848x848. Diabetic retinopathy graded by the modified Davis classification. 45-degree field of view:
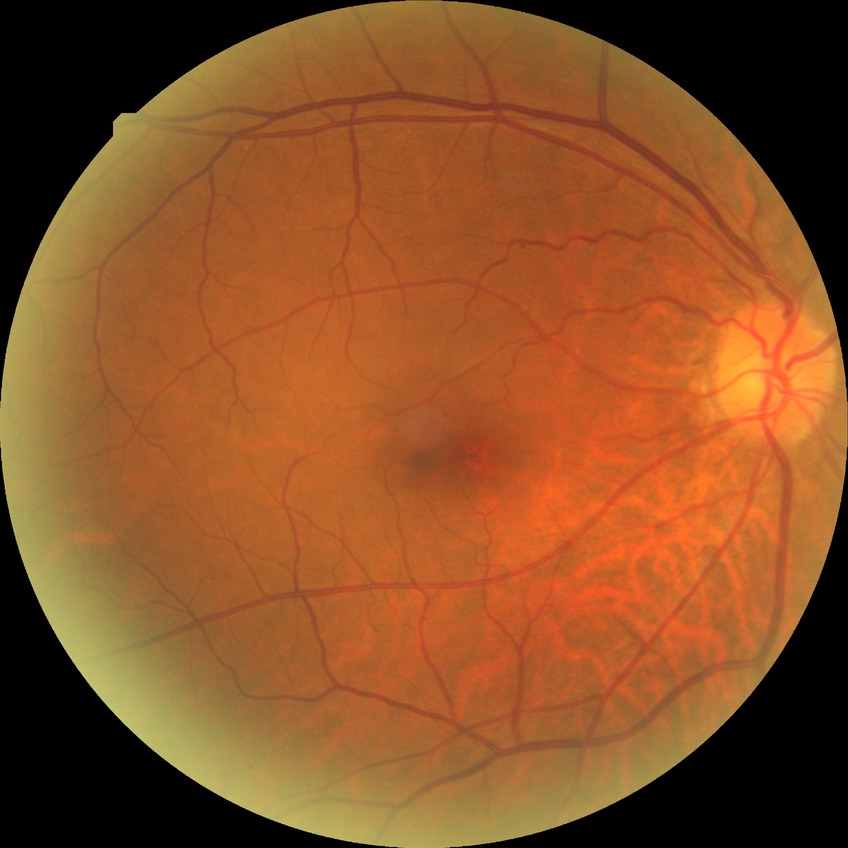
diabetic retinopathy (DR) = NDR (no diabetic retinopathy).